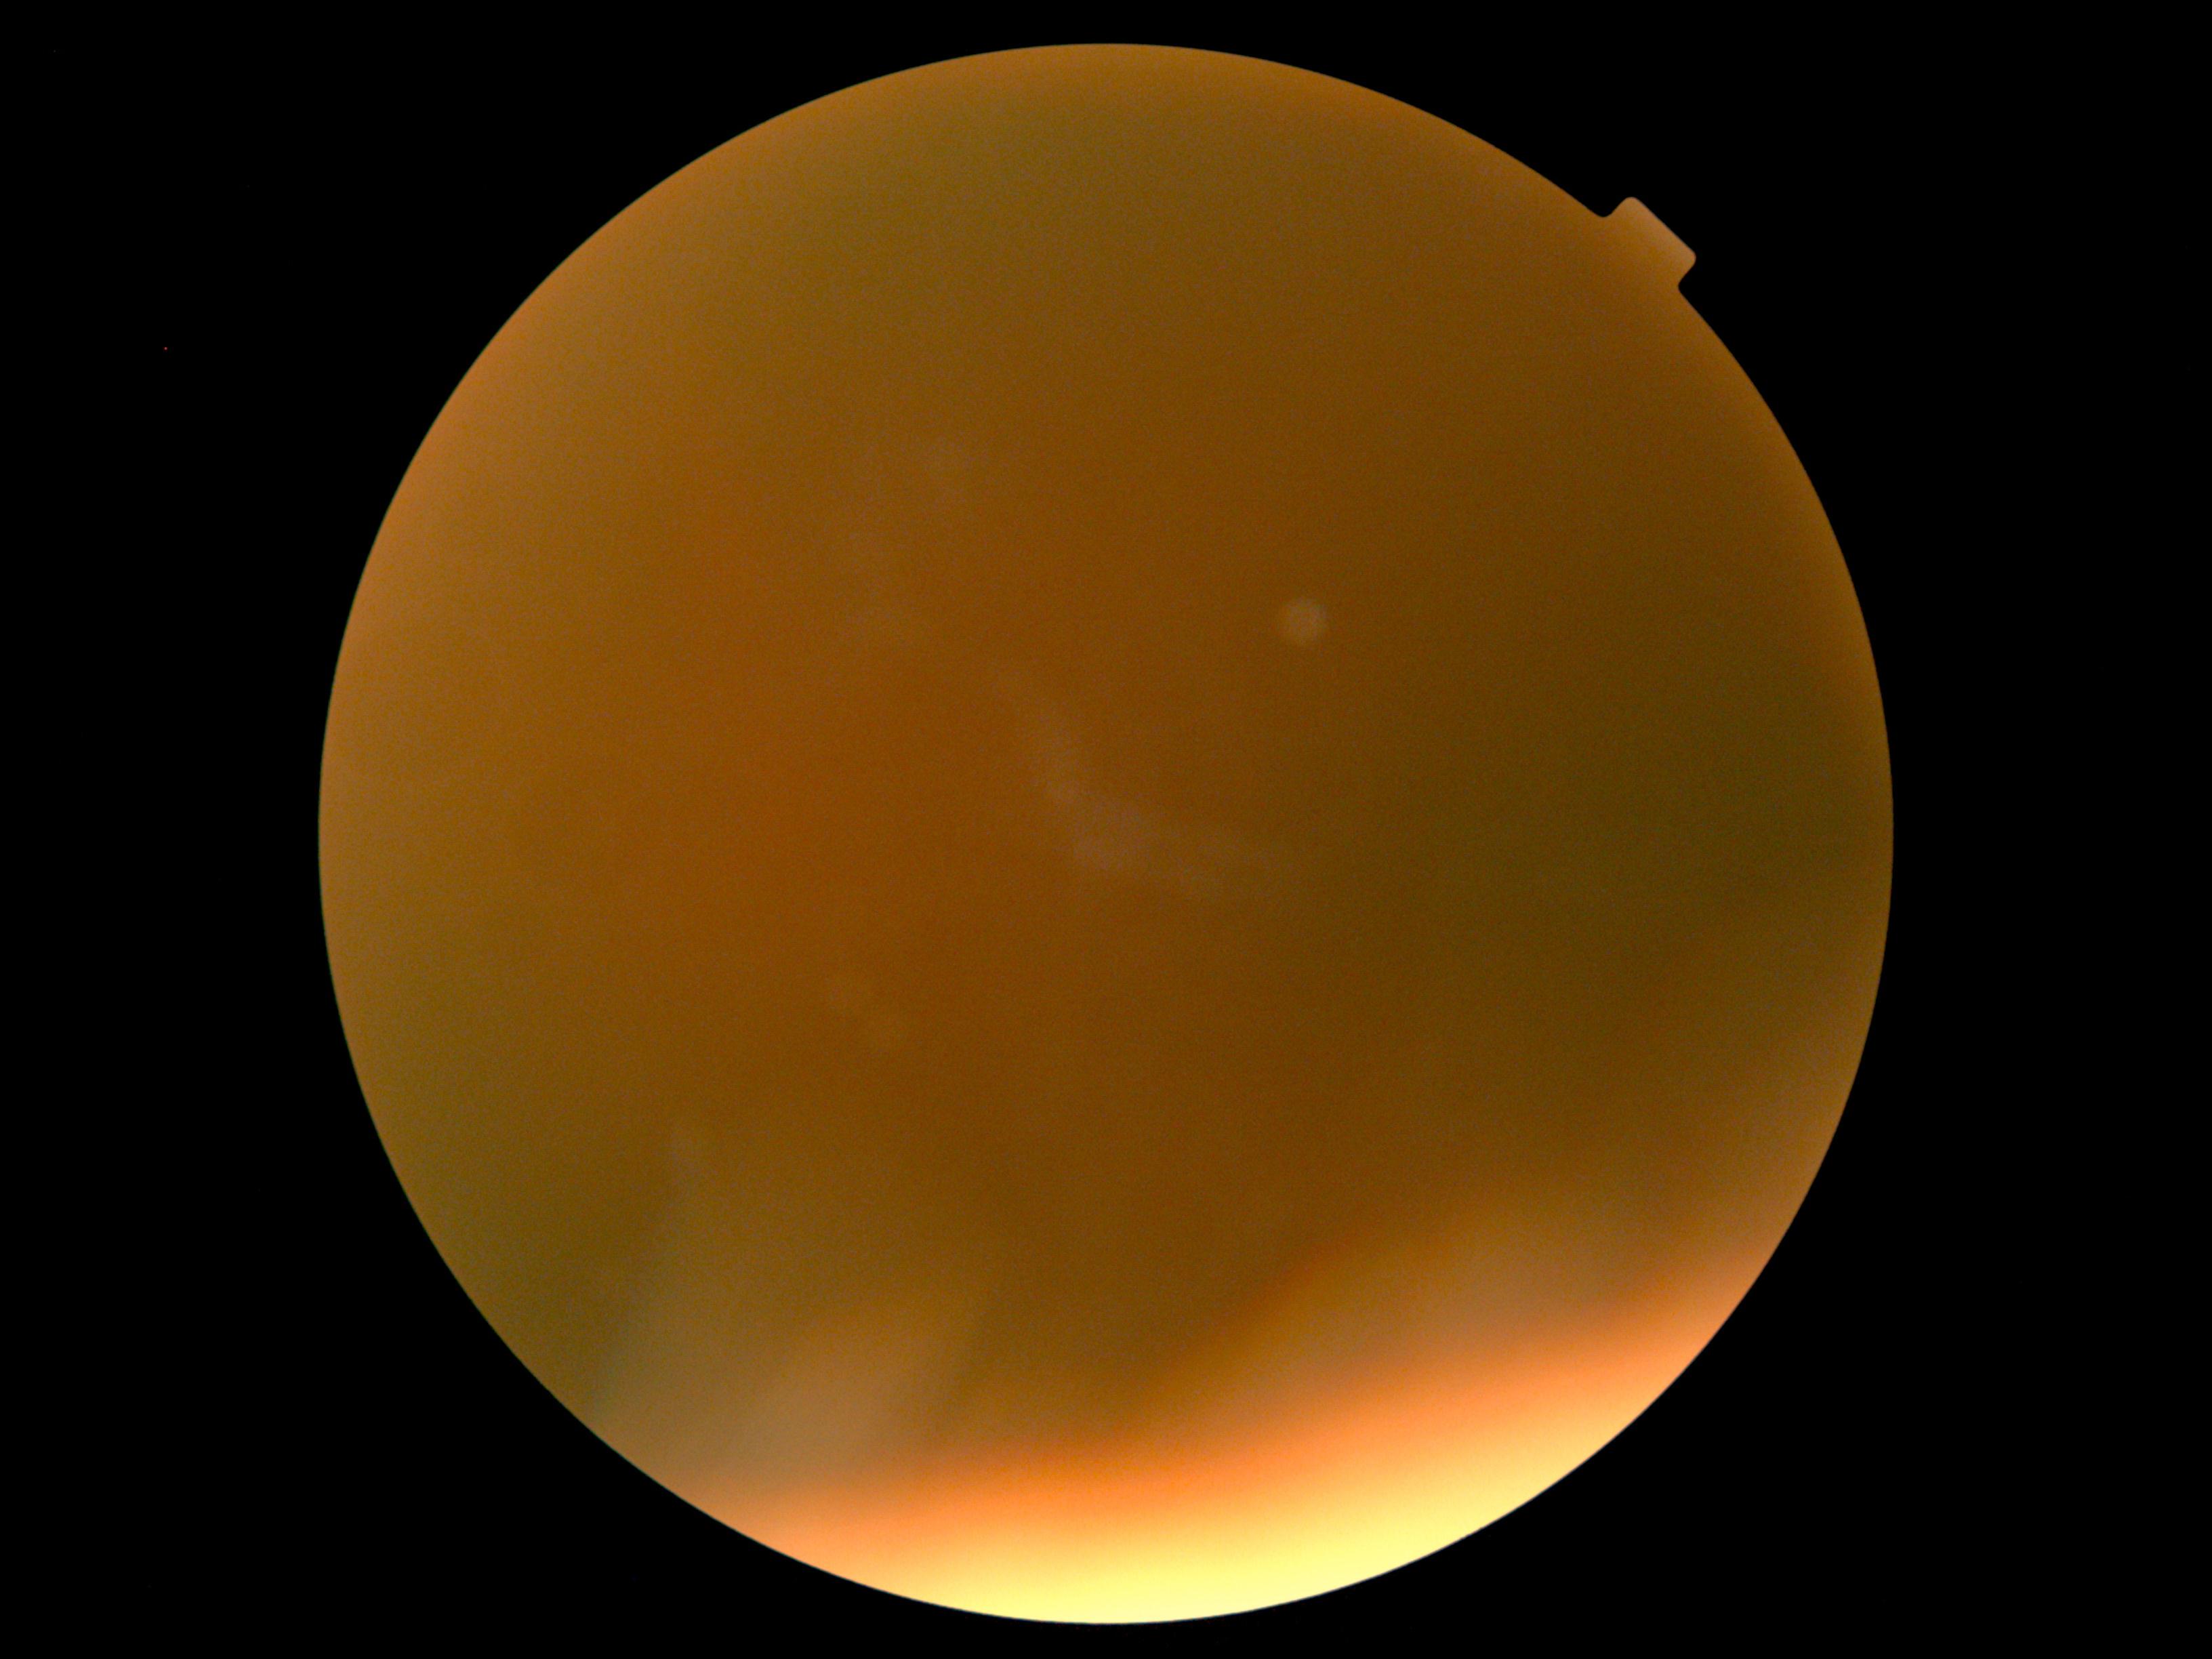

DR: ungradable due to poor image quality.